Autorefraction: sphere +2 D, cylinder -1.5 D, axis 120°; axial length: 22.42 mm; female; intraocular pressure (IOP): 18 mmHg; pachymetry 543 µm; Topcon TRC-NW400; CFP; age 80.
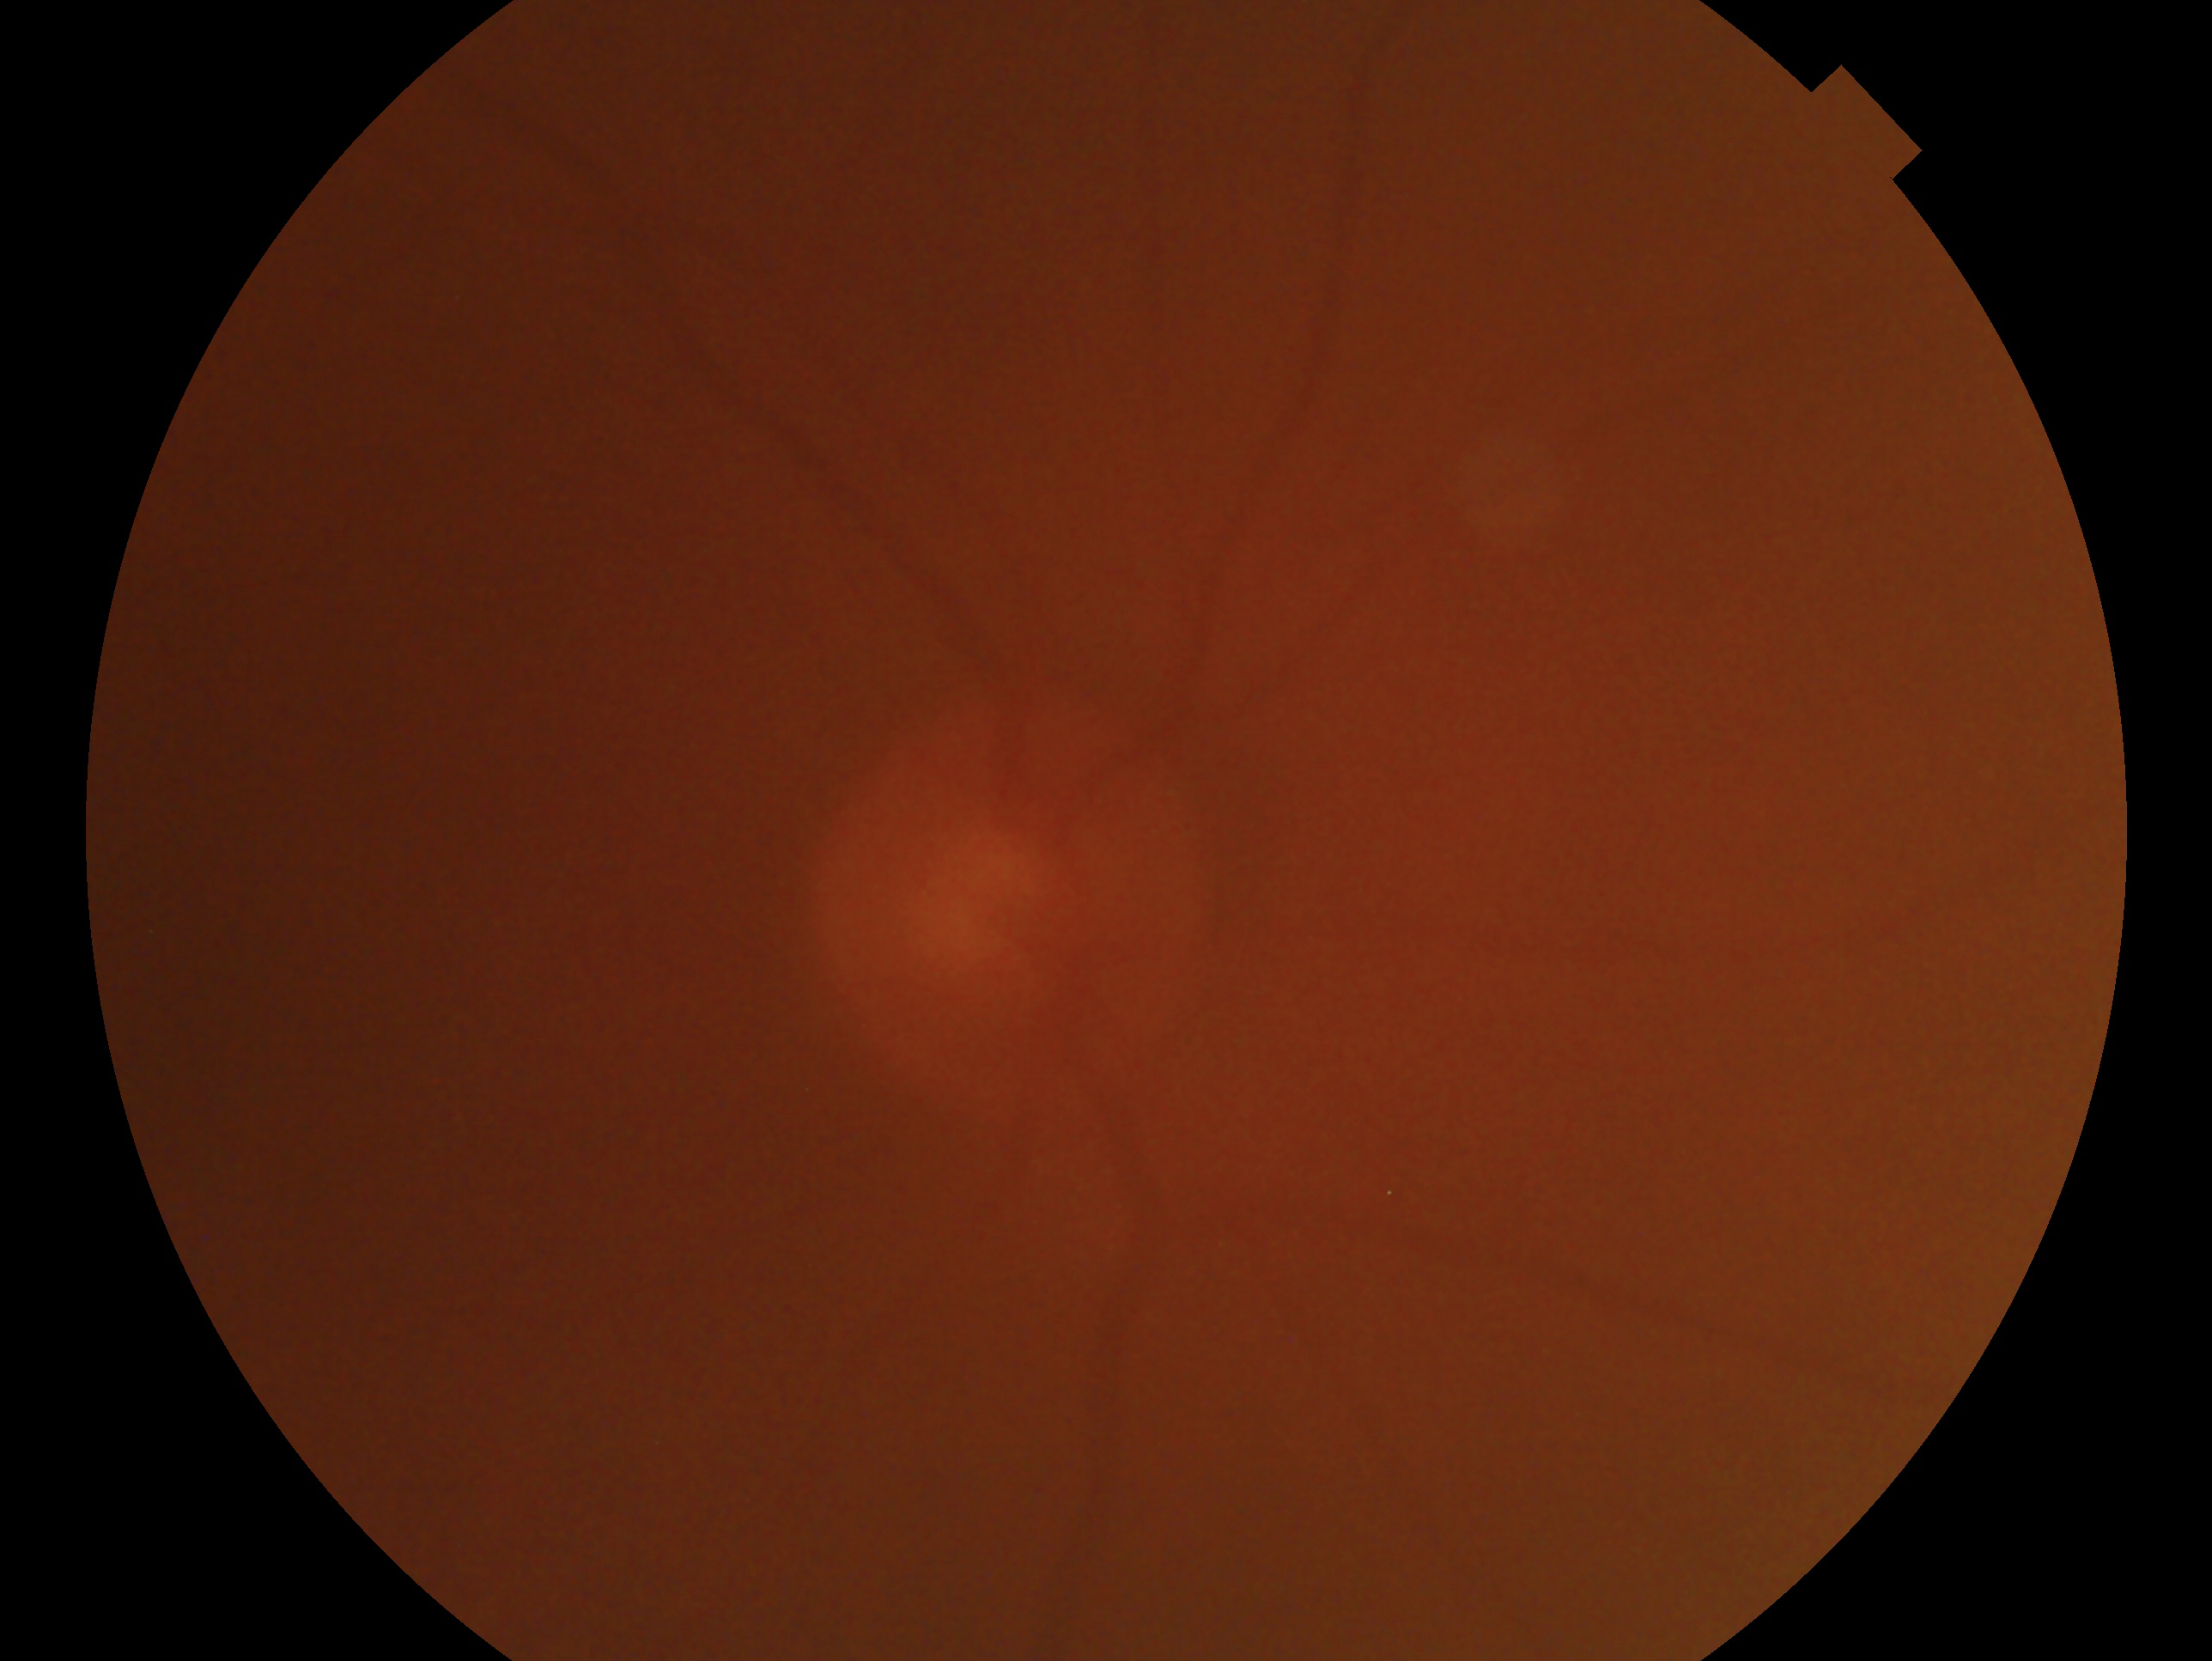 {
  "eye": "right",
  "glaucoma_dx": "cannot be excluded"
}